Color fundus image.
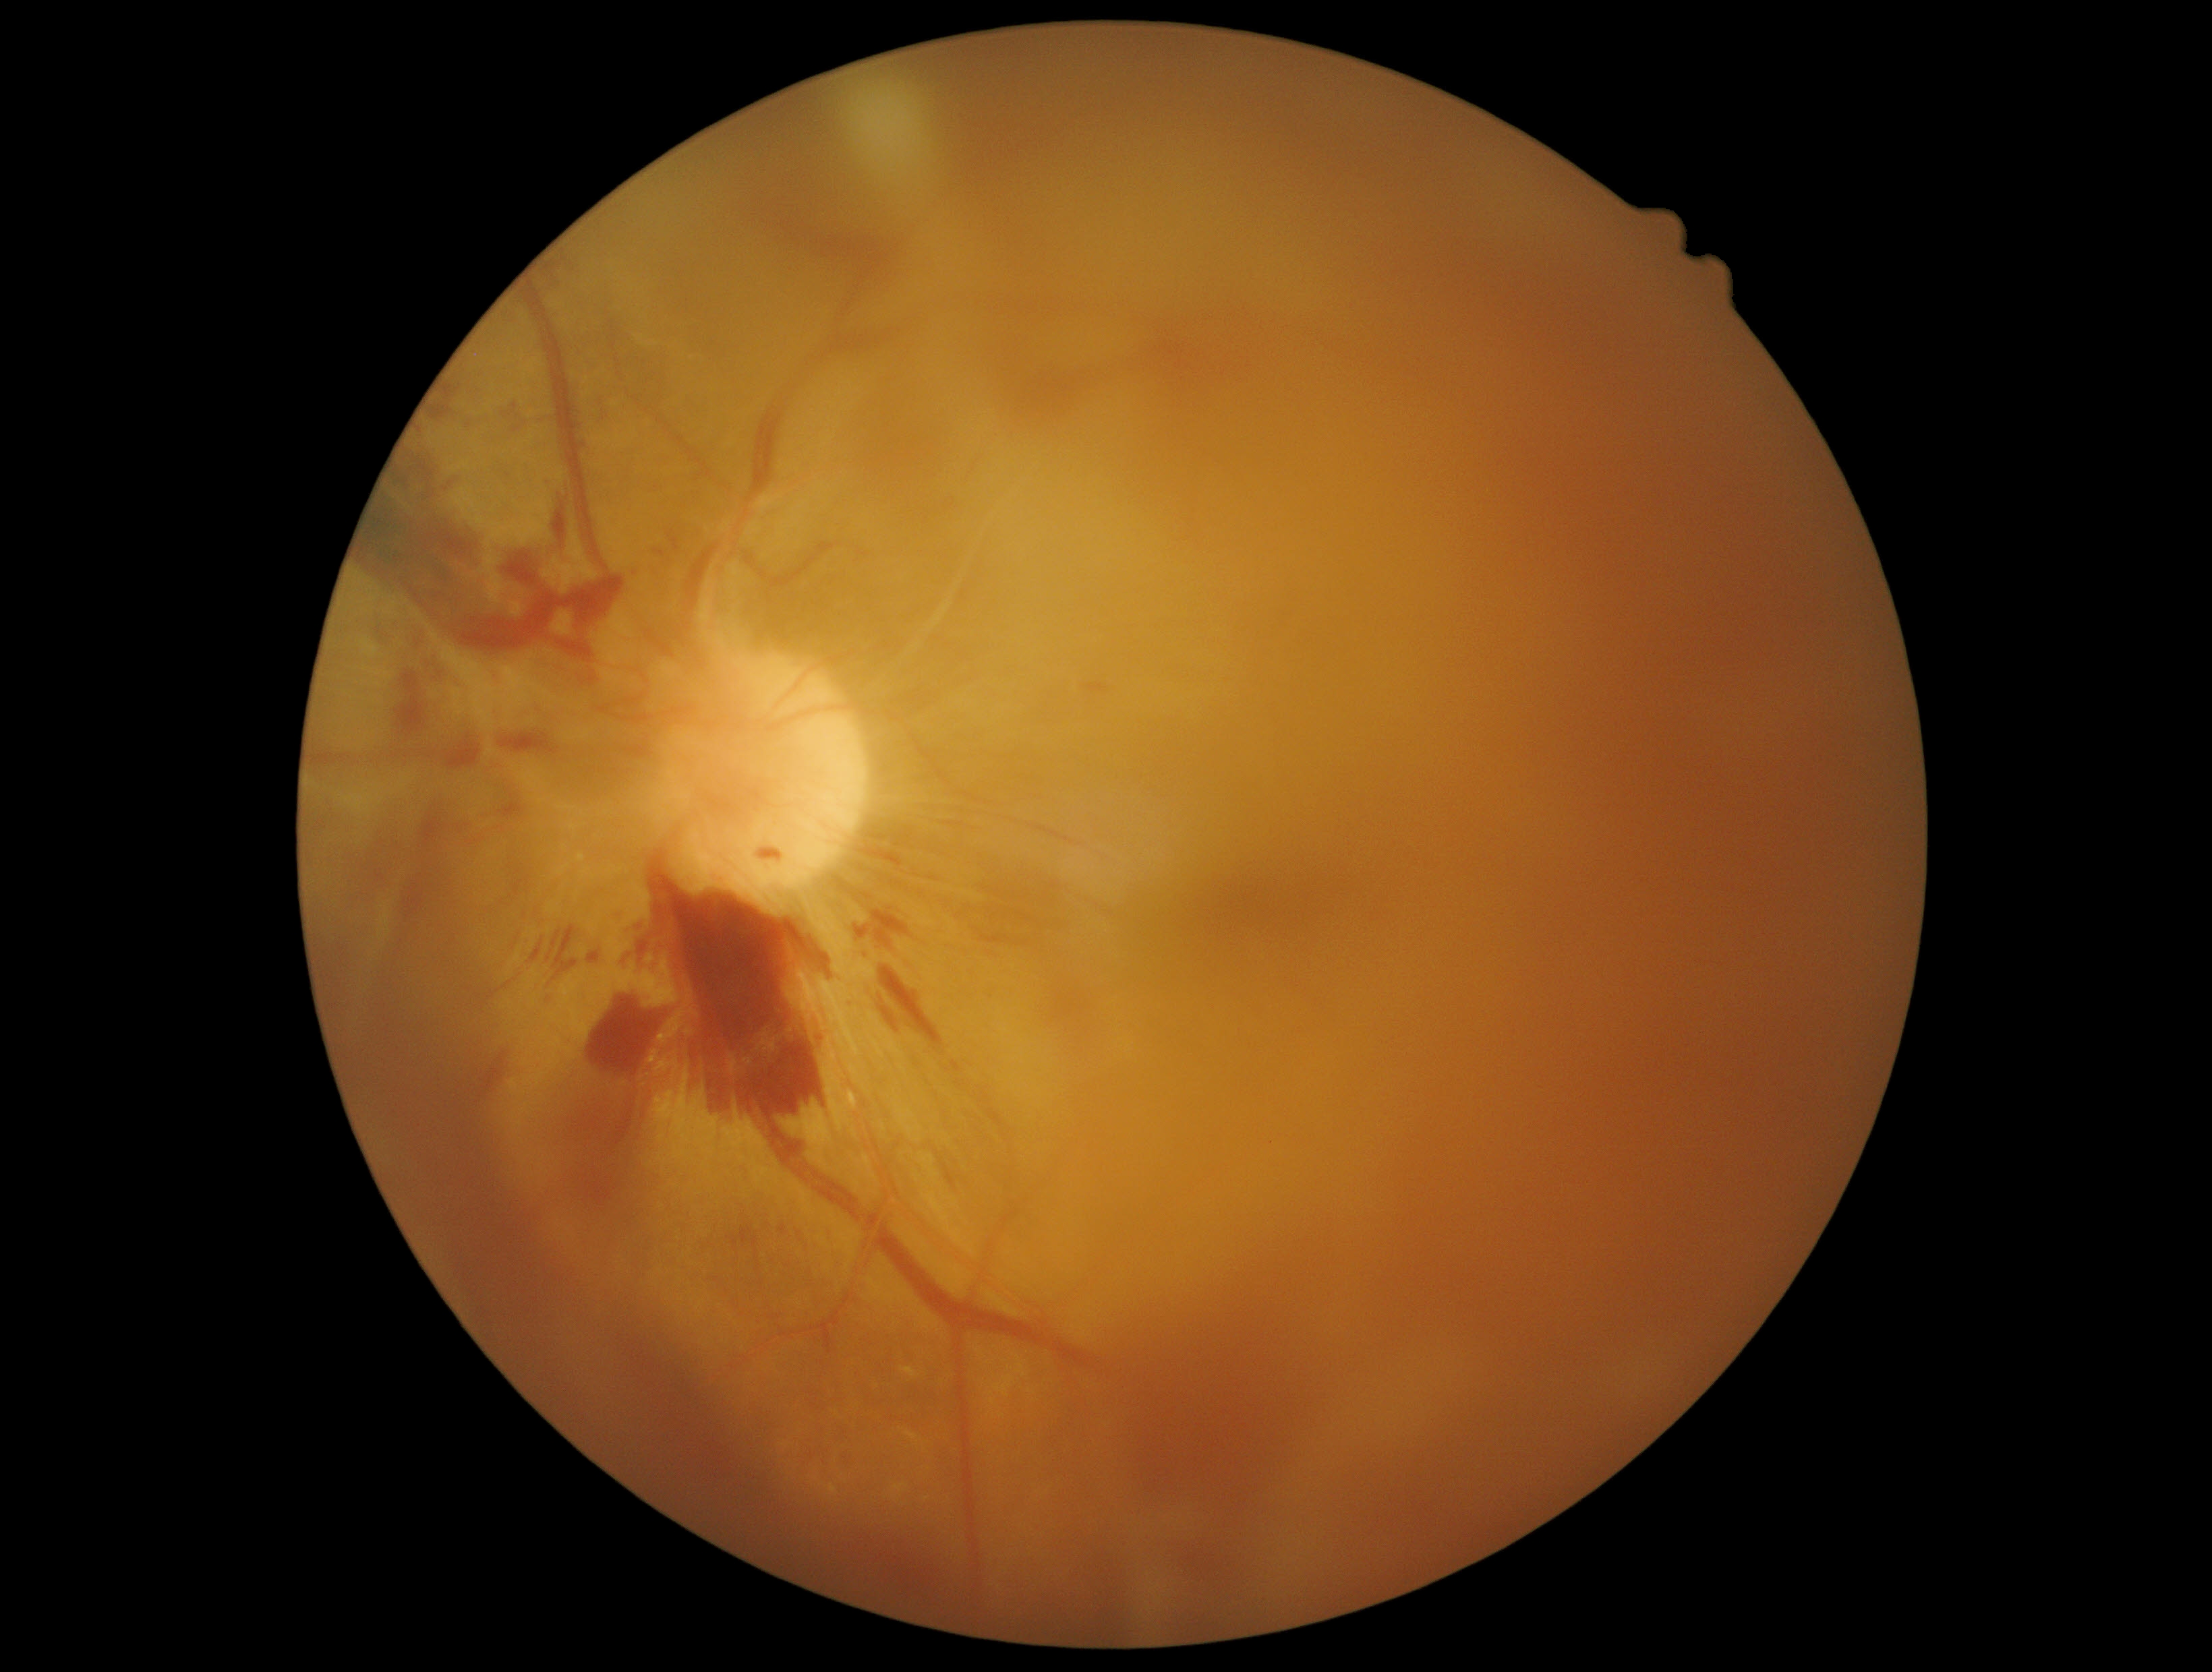

partial: true
dr_grade: 4
dr_grade_name: PDR
lesions:
  se: []
  ex: []
  he:
    - 806, 1318, 844, 1356
    - 500, 401, 527, 434
    - 498, 730, 562, 757
    - 653, 548, 672, 563
    - 416, 640, 424, 649
    - 725, 1205, 771, 1276
    - 578, 668, 601, 687
    - 357, 448, 627, 667
    - 637, 942, 648, 961
    - 645, 629, 652, 644
    - 854, 905, 915, 951
    - 401, 802, 471, 923
    - 602, 412, 609, 421
    - 508, 860, 532, 903
  he_small_approx:
    - Point(336, 633)
    - Point(371, 583)
  ma: []